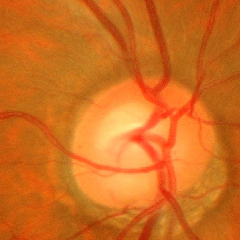 Optic disc appearance consistent with early glaucomatous changes.